CFP · non-mydriatic acquisition
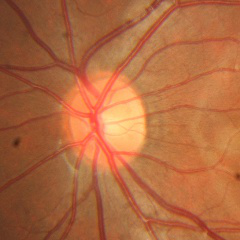
No signs of glaucoma.